Tabletop color fundus camera image:
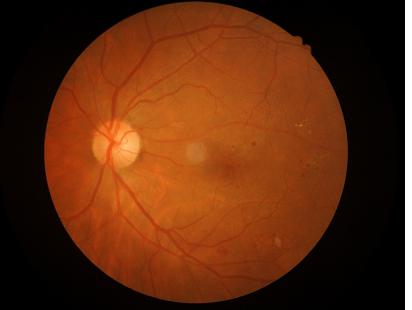

Clarity: good; Overall quality: good.